640 x 480 pixels. Wide-field contact fundus photograph of an infant: 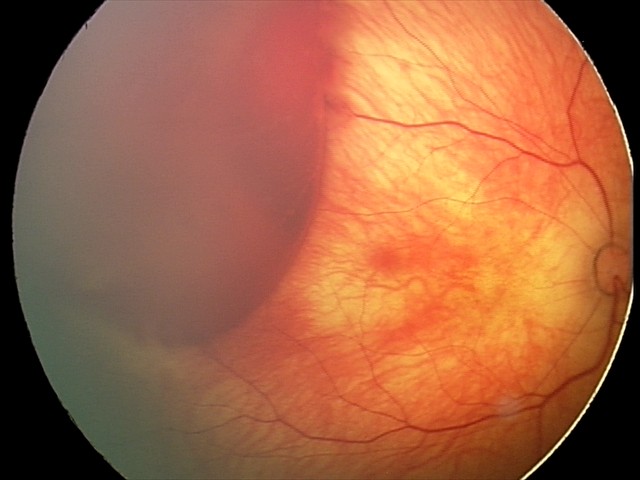

Diagnosis: retinal hemorrhages.